45° FOV: 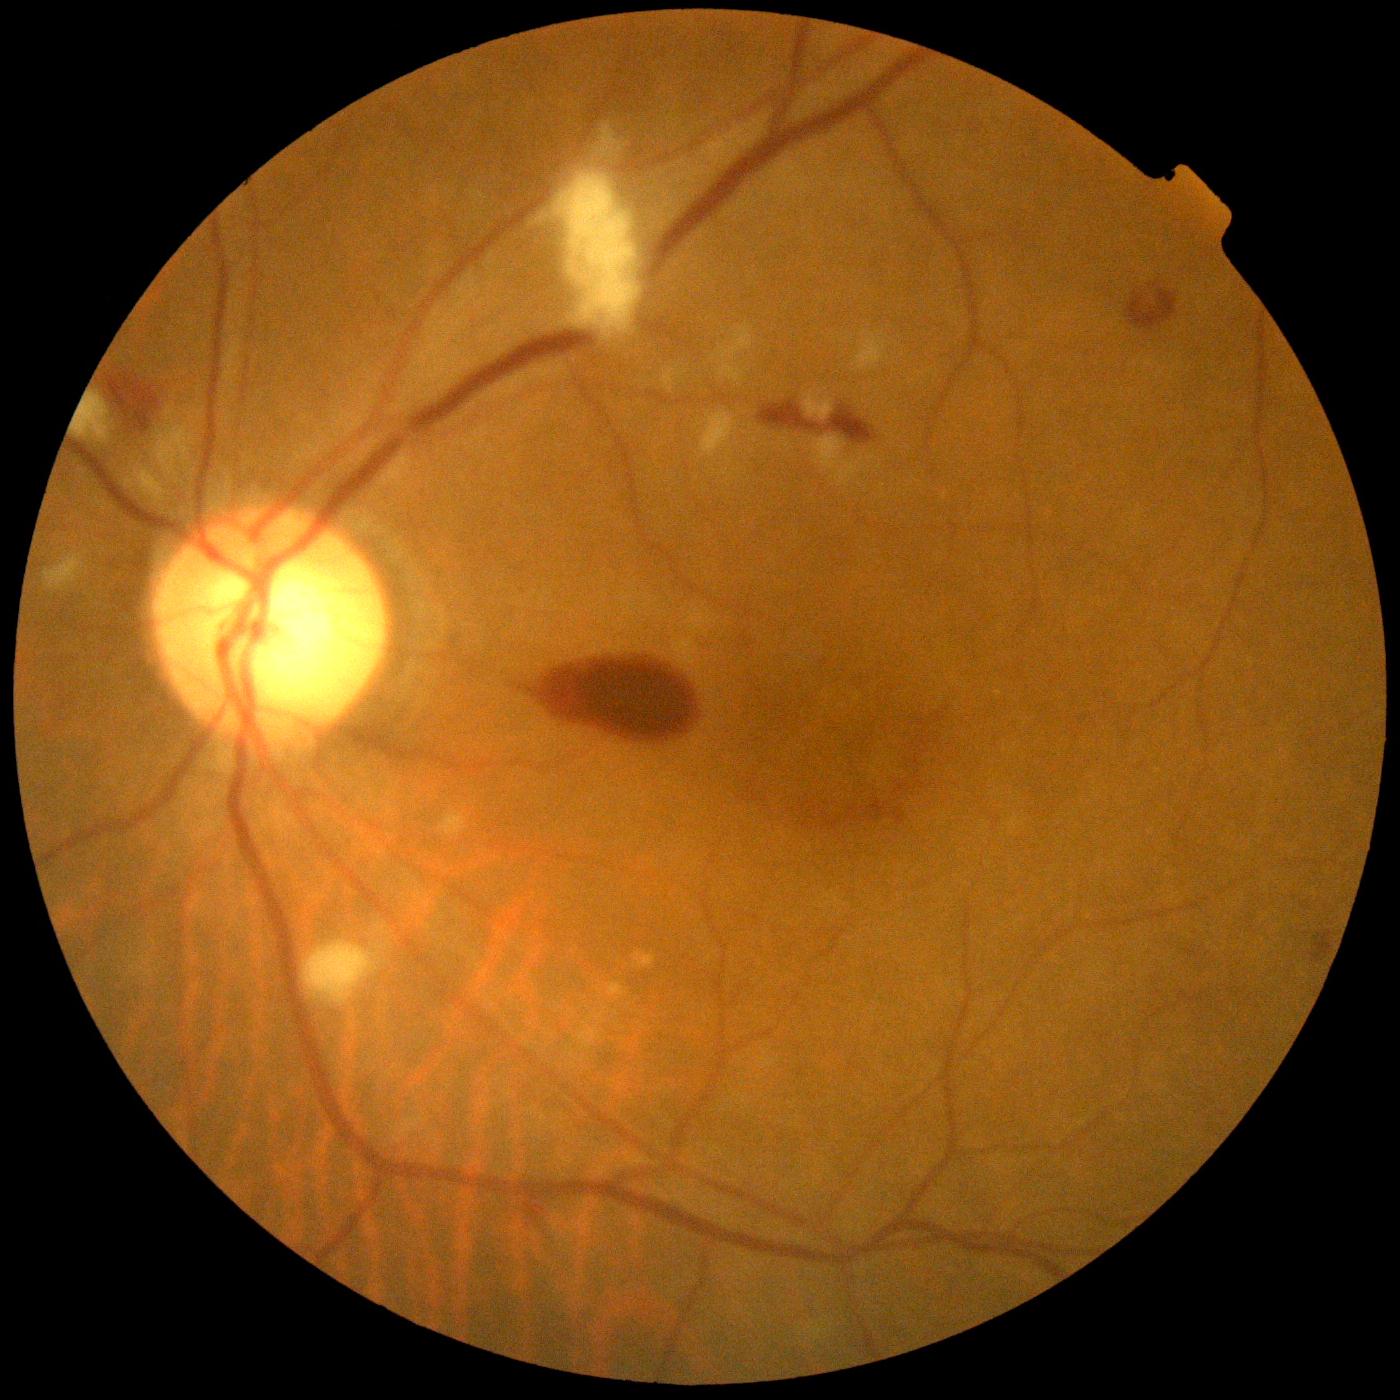

DR: PDR (grade 4)
- SEs: region(555, 171, 641, 332) | region(853, 334, 887, 371) | region(76, 395, 108, 438) | region(440, 811, 468, 836) | region(595, 122, 622, 155) | region(813, 436, 865, 488) | region(804, 390, 834, 421) | region(304, 941, 379, 1005) | region(702, 412, 738, 457) | region(152, 402, 197, 479) | region(44, 550, 90, 593) | region(718, 323, 753, 383) | region(125, 467, 163, 497)
- EXs: none detected
- HEs: region(1310, 931, 1333, 963) | region(544, 649, 692, 740) | region(758, 402, 822, 432) | region(1127, 289, 1178, 330) | region(105, 374, 160, 434) | region(826, 406, 879, 445)
- MAs: region(894, 809, 905, 826) | region(870, 801, 889, 821)